640x480px · 130° field of view (Clarity RetCam 3) · RetCam wide-field infant fundus image:
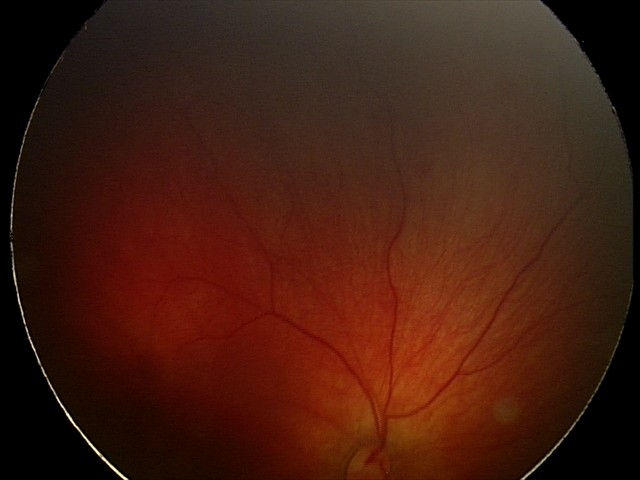
Assessment: retinal hemorrhages.